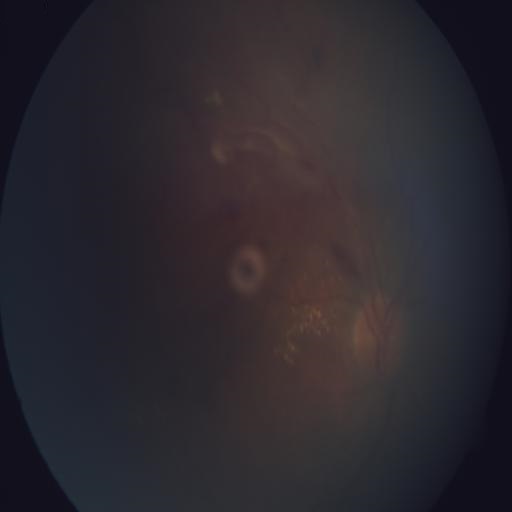
2 findings. Findings consistent with BRVO (branch retinal vein occlusion) and EDN (exudation).